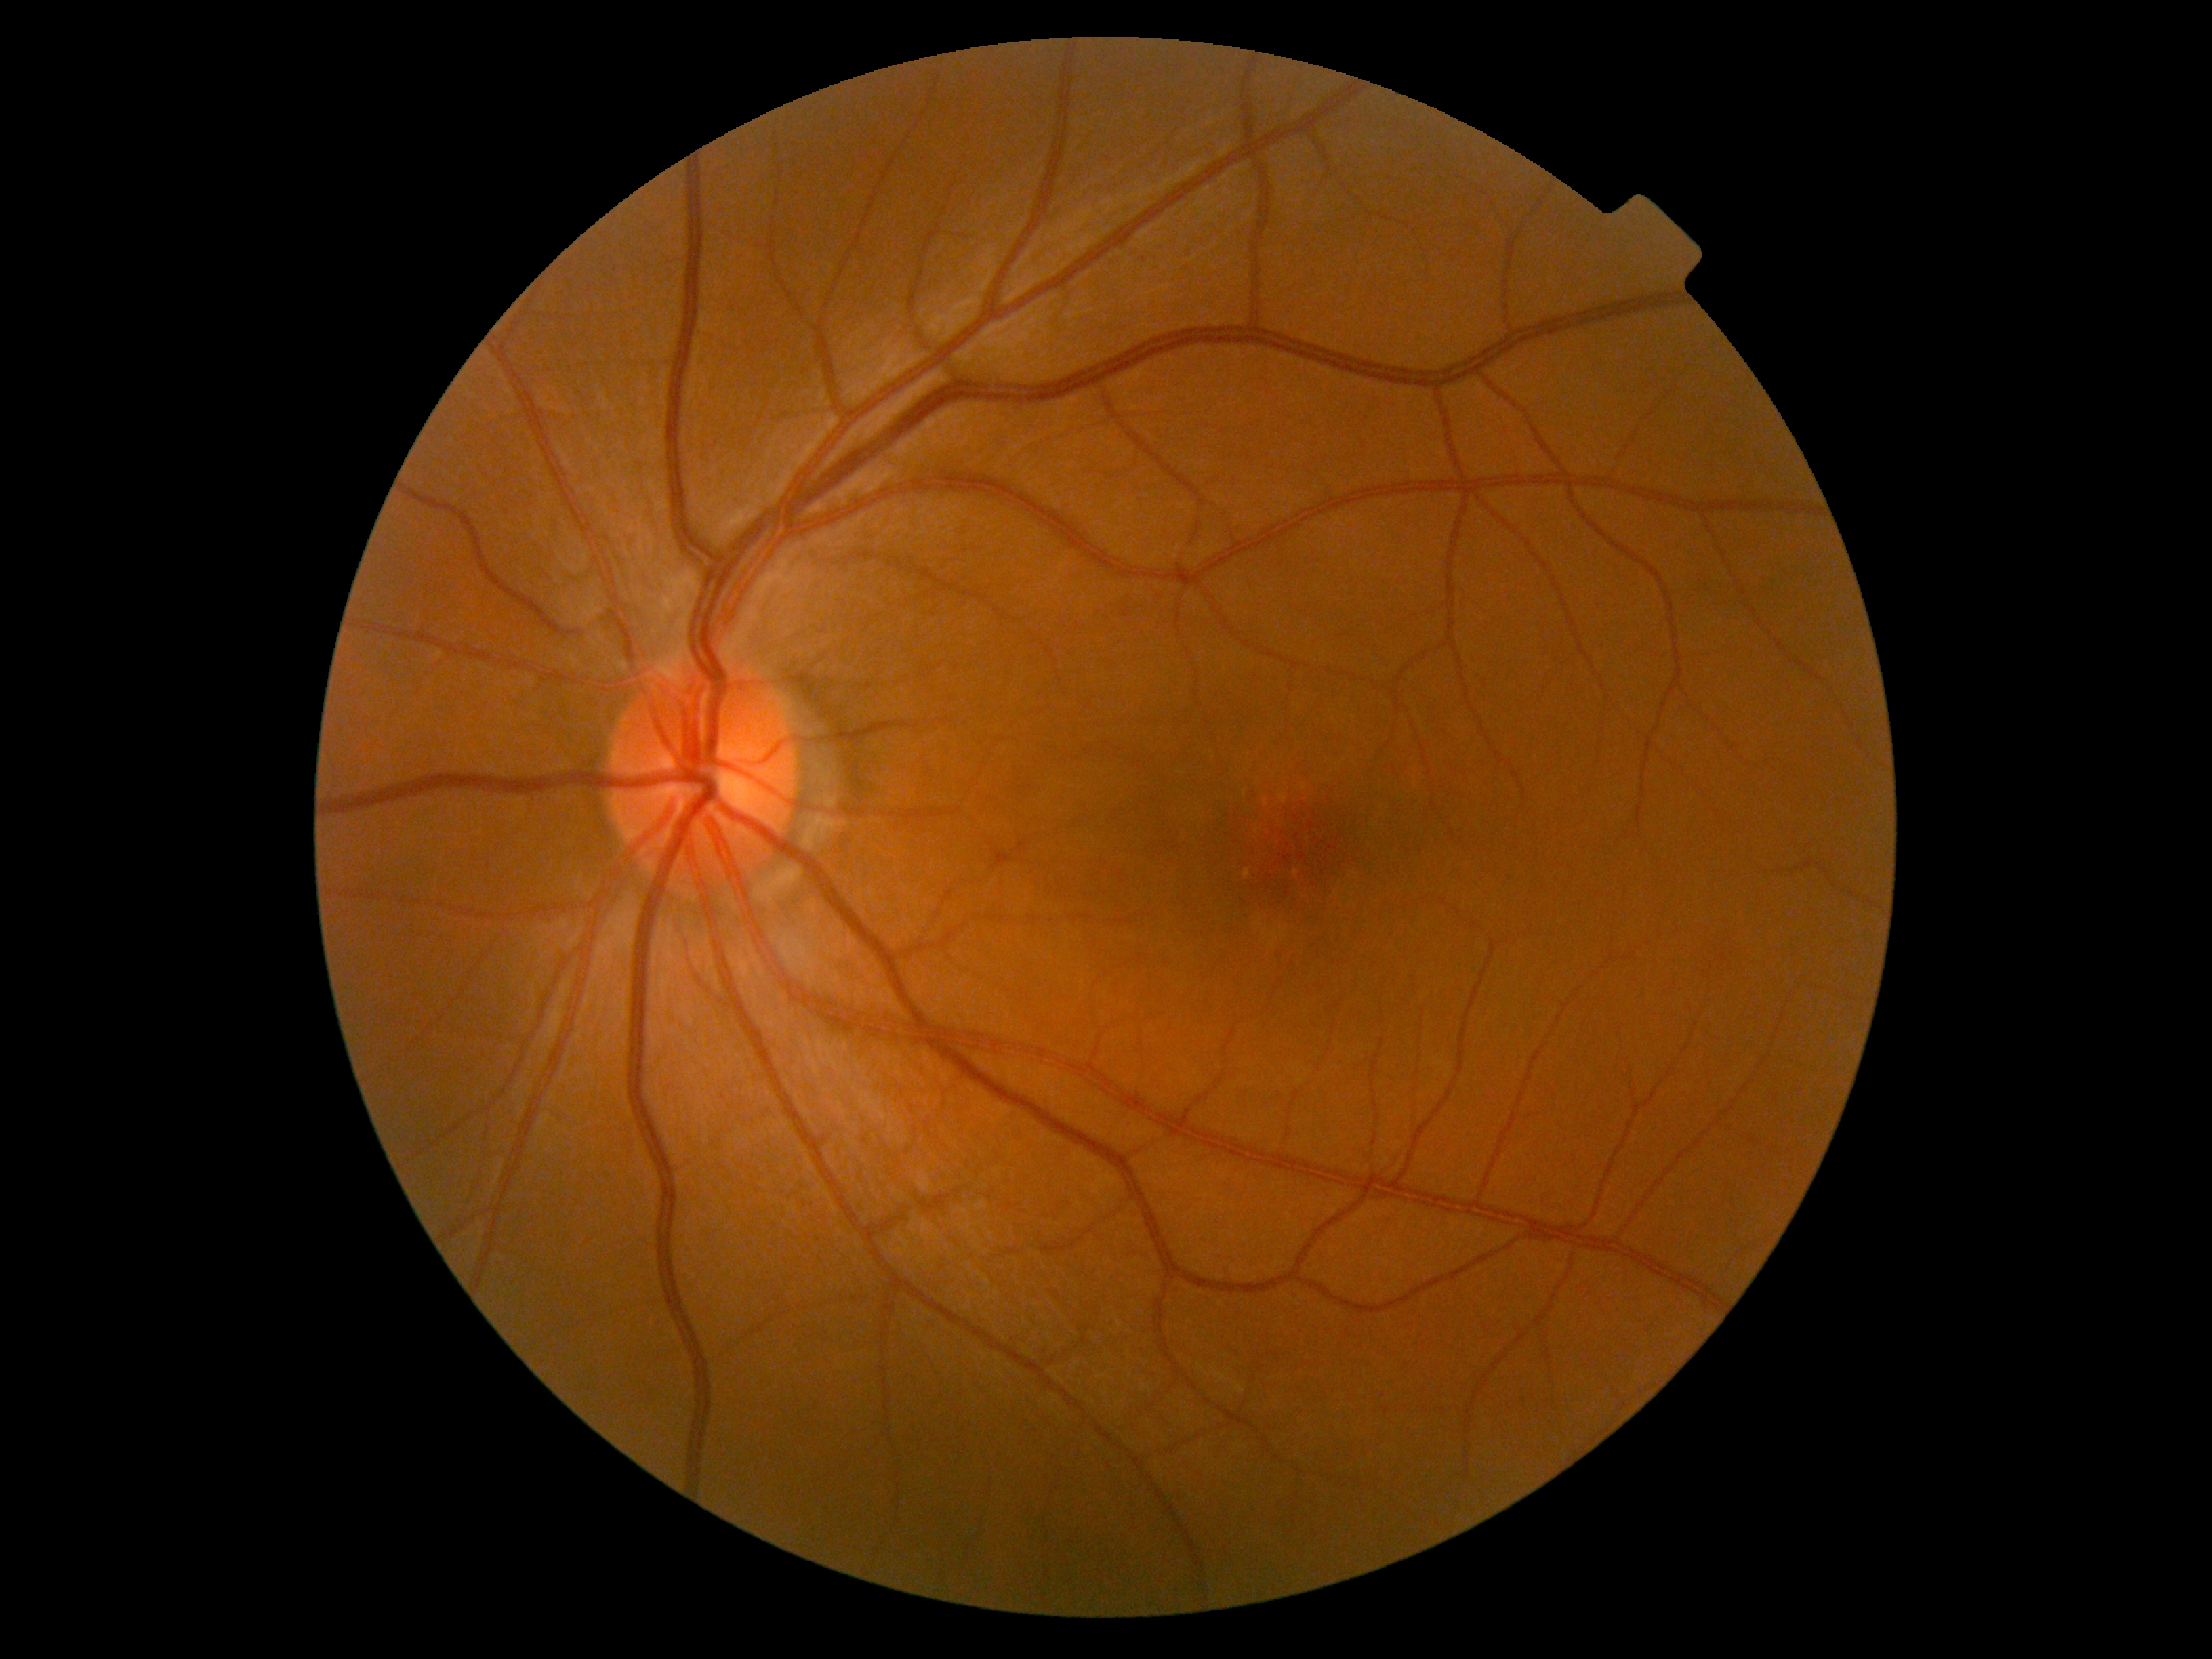

DR severity is grade 0 (no apparent retinopathy).